Wide-field fundus photograph from neonatal ROP screening — 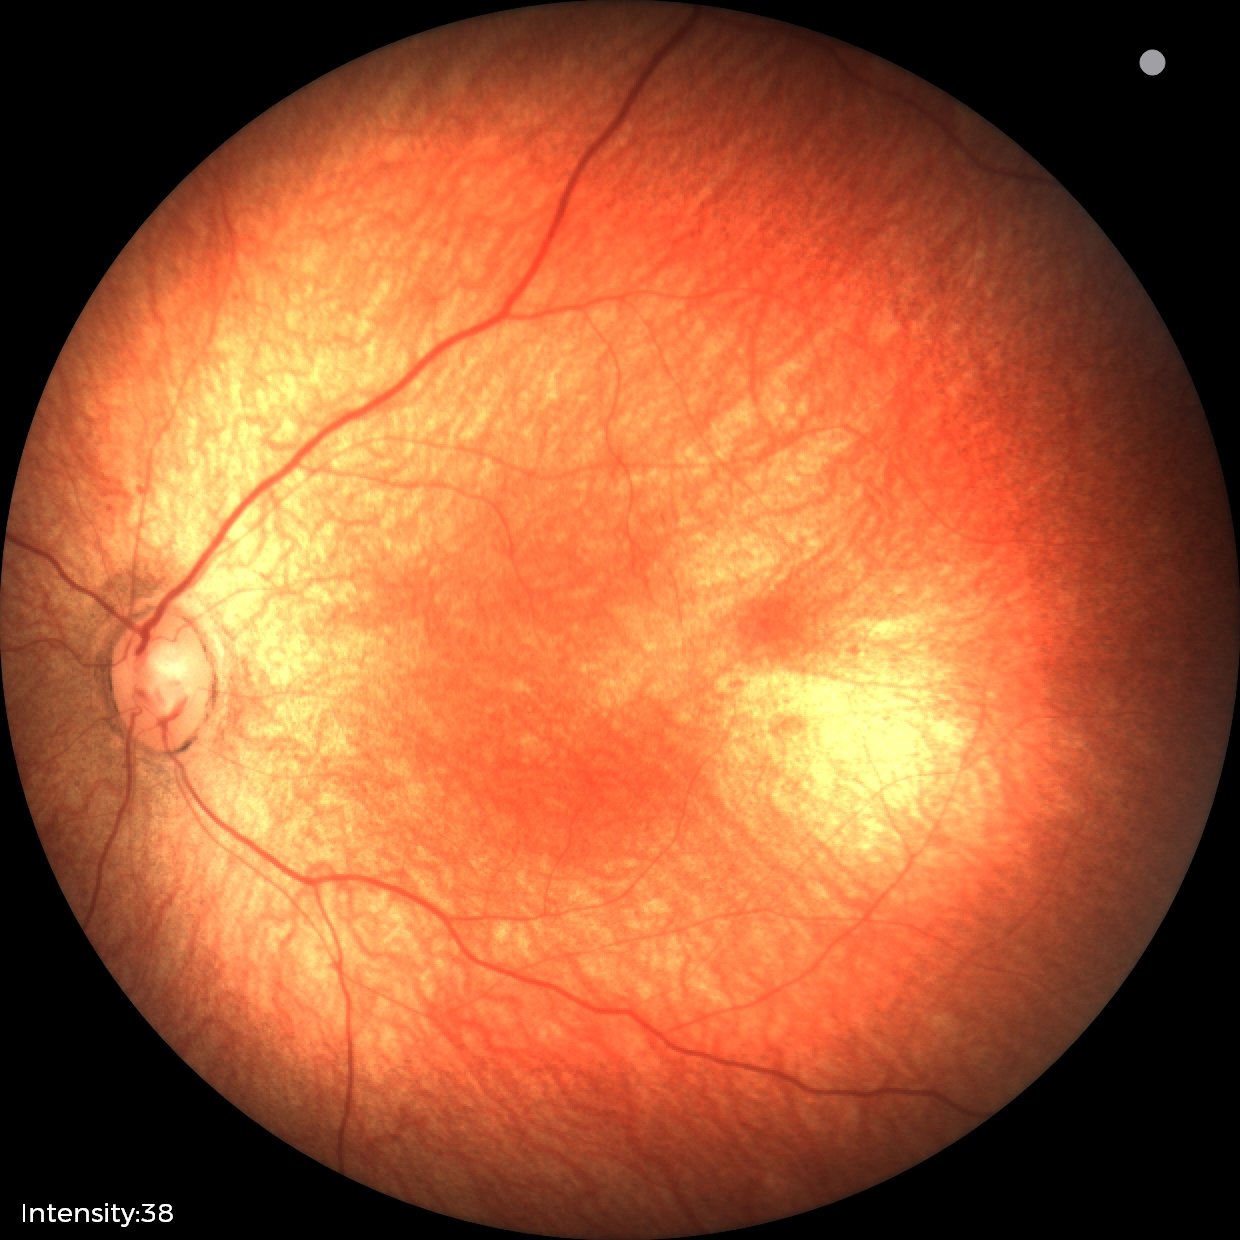 Q: What is the screening diagnosis?
A: physiological retinal finding